Wide-field fundus photograph from neonatal ROP screening. Acquired on the Clarity RetCam 3: 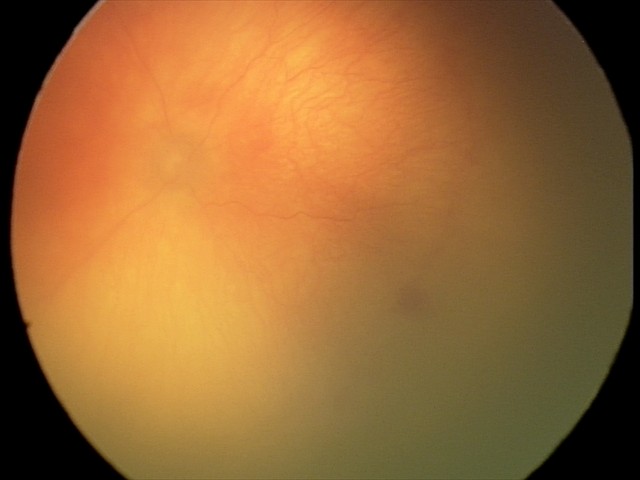
Screening series with aggressive retinopathy of prematurity.
With plus disease.